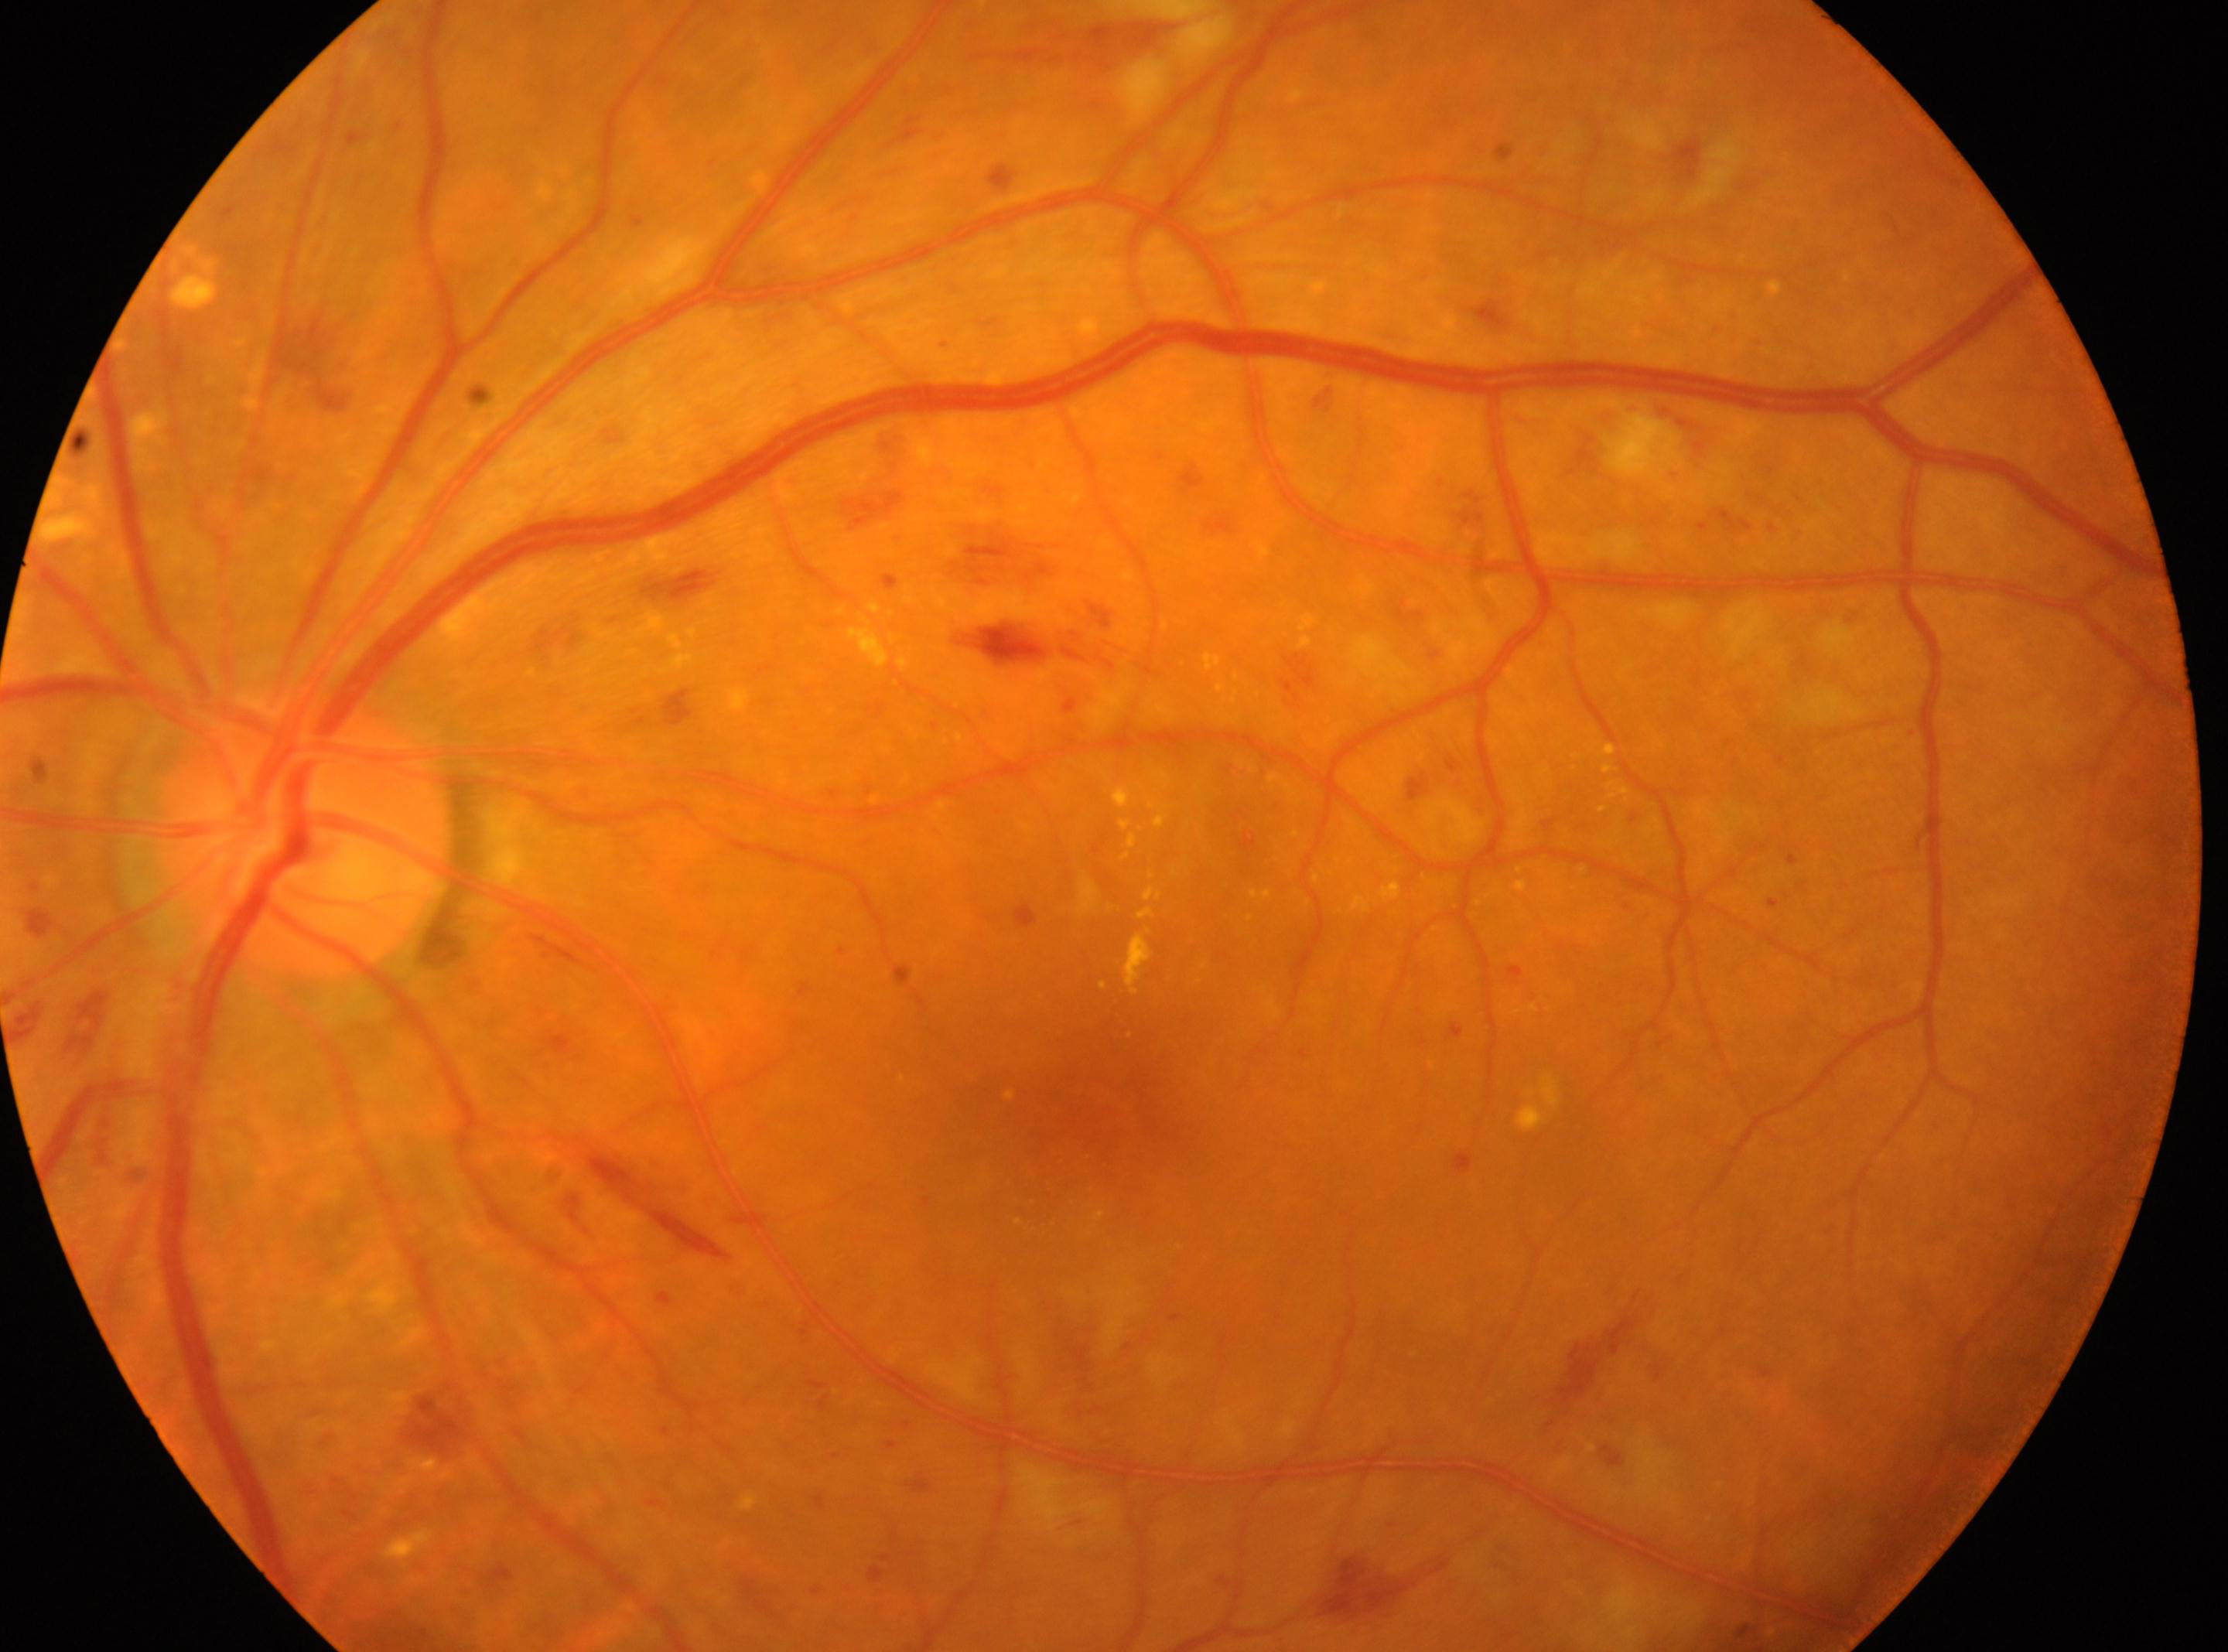

DR class: non-proliferative diabetic retinopathy.
Diabetic retinopathy (DR): severe non-proliferative diabetic retinopathy (grade 3).
Optic disc located at (307,832).
Eye: left.
The fovea centralis is at (1083,1100).